Color fundus photograph, 2212x1659px: 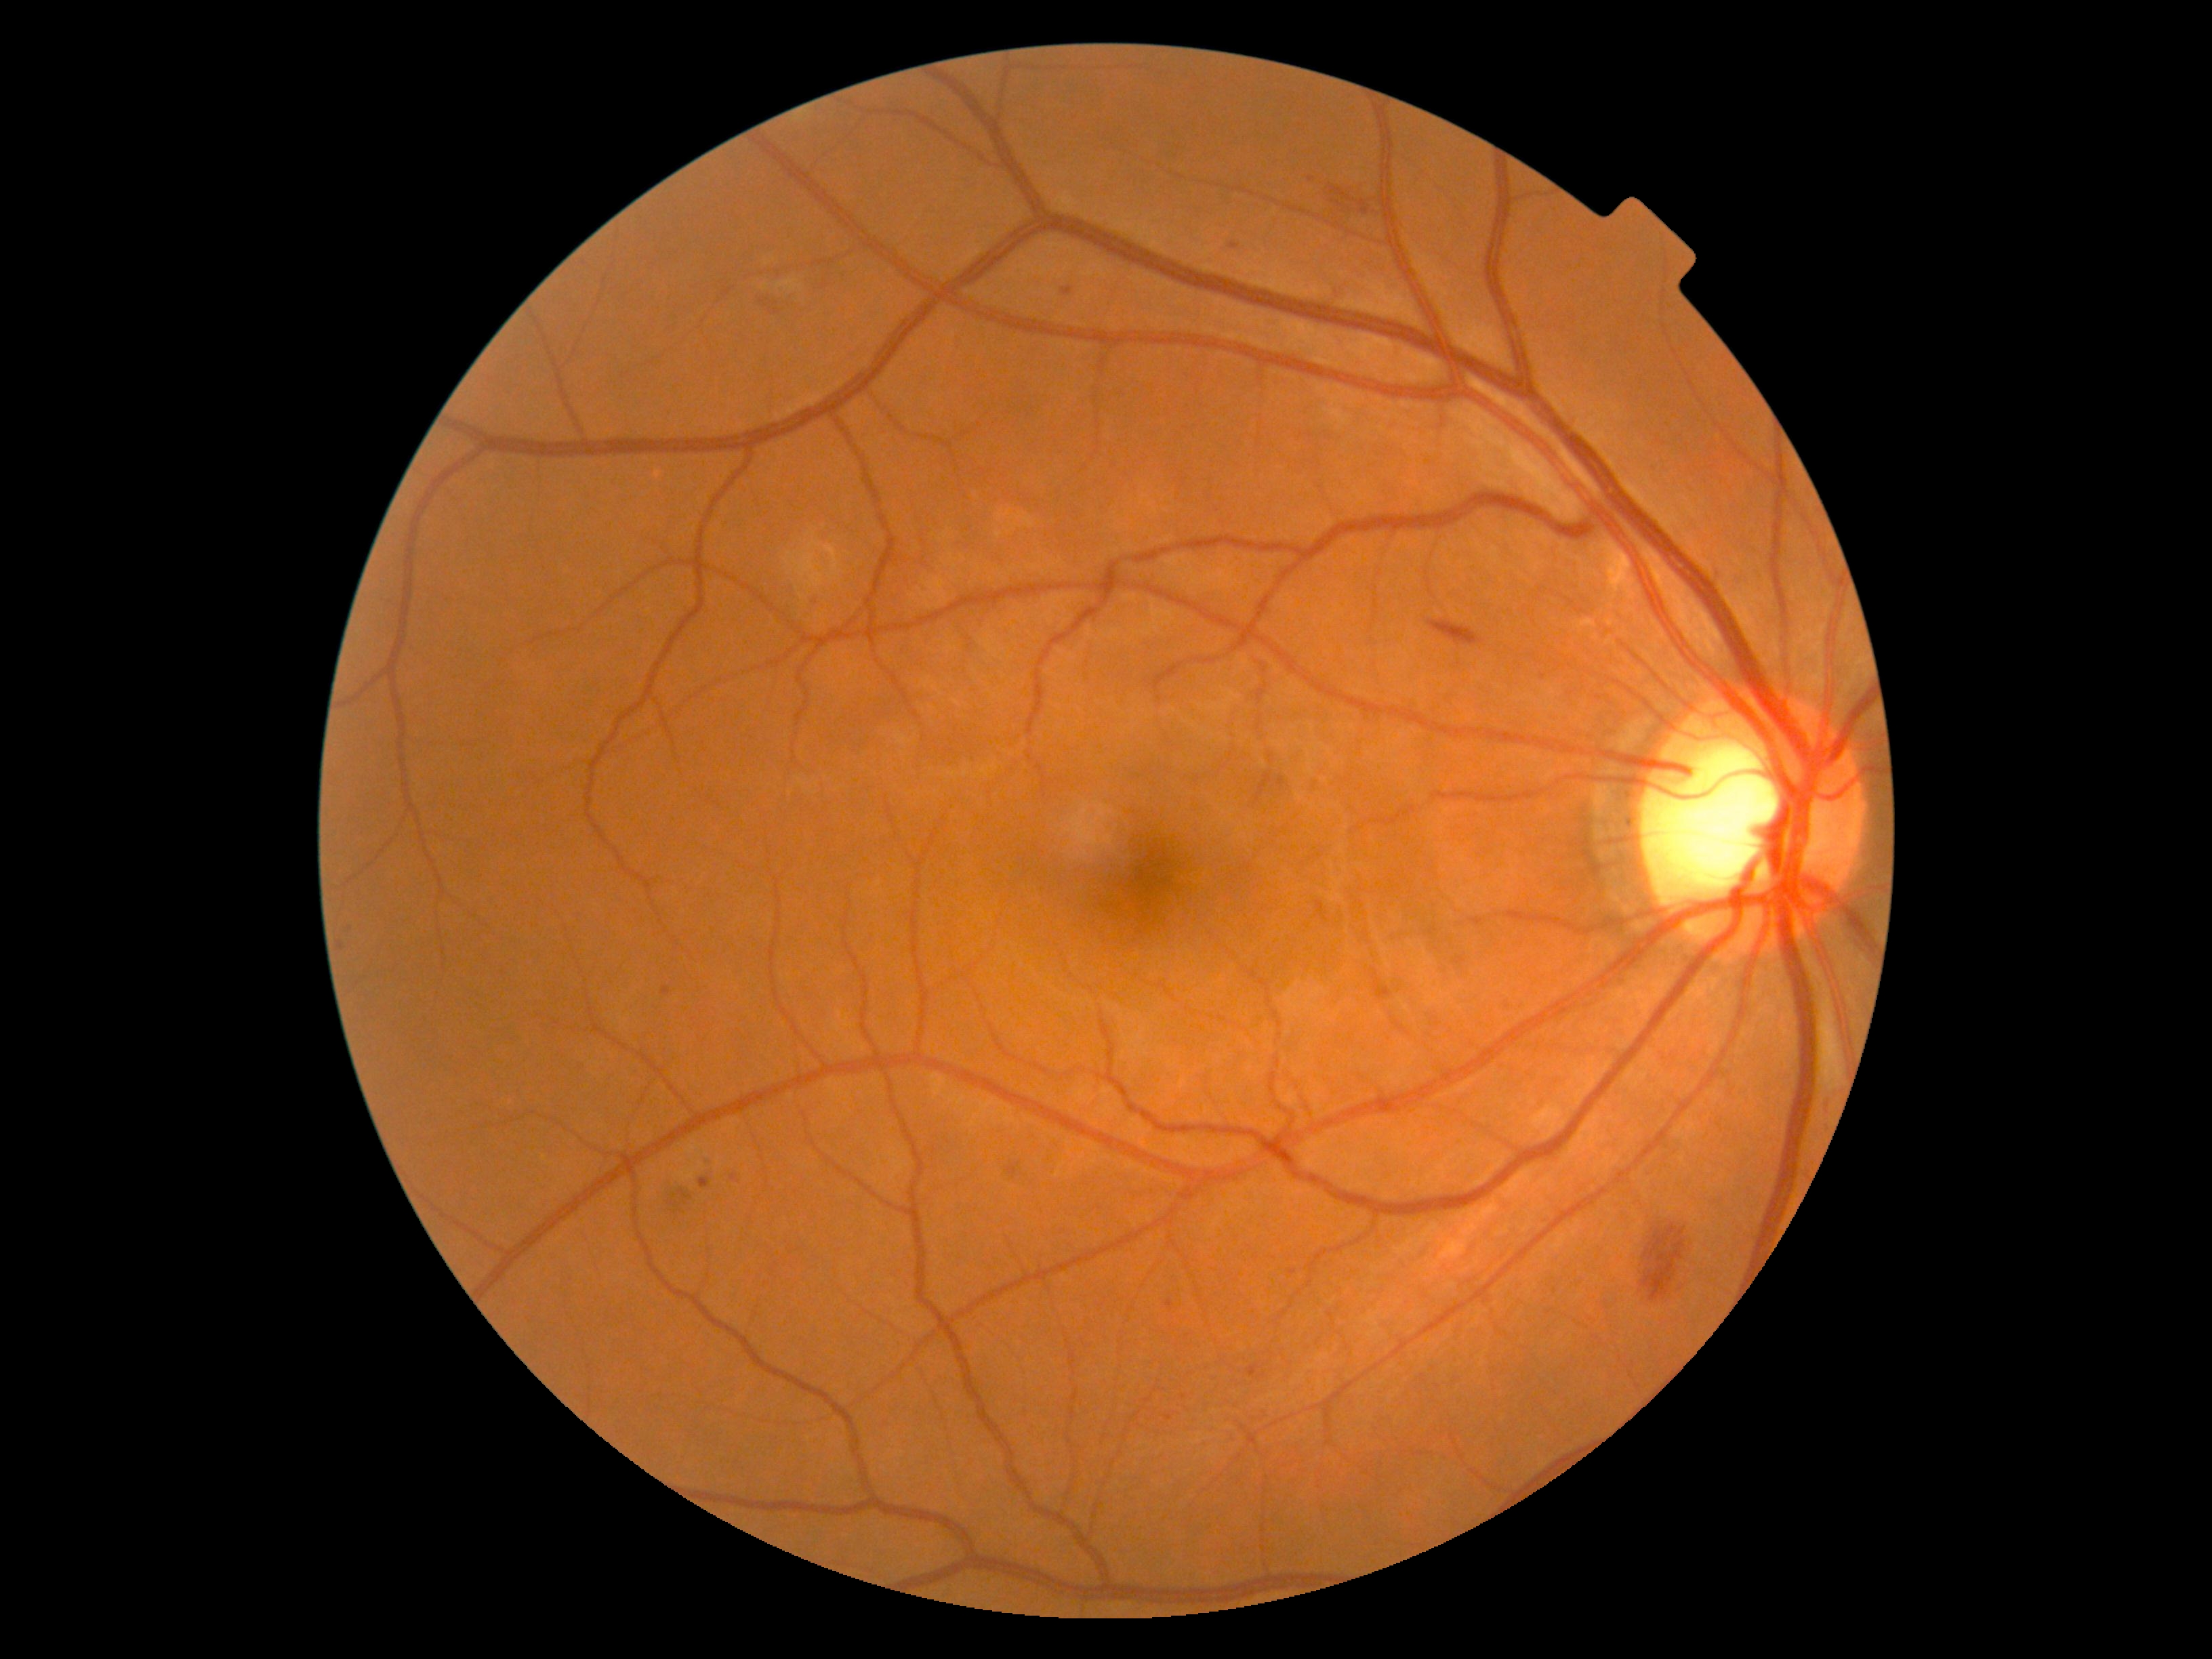

Diabetic retinopathy grade: 2. Soft exudates identified at BBox(777, 280, 803, 292), BBox(762, 284, 769, 292). Soft exudates (small, approximate centers) near {"x": 767, "y": 262}. Microaneurysms include those at BBox(338, 941, 344, 949), BBox(1165, 1414, 1173, 1420), BBox(1006, 1164, 1020, 1177), BBox(700, 1155, 711, 1164), BBox(700, 1177, 711, 1188), BBox(661, 986, 670, 996), BBox(1062, 288, 1073, 295), BBox(802, 598, 815, 608), BBox(1277, 777, 1286, 788), BBox(1290, 1269, 1298, 1273), BBox(1248, 1363, 1263, 1378). Microaneurysms (small, approximate centers) near {"x": 1234, "y": 247}, {"x": 734, "y": 1177}, {"x": 350, "y": 928}, {"x": 1311, "y": 180}, {"x": 1169, "y": 1303}. Hemorrhages identified at BBox(758, 295, 781, 311), BBox(1428, 620, 1483, 646), BBox(1332, 200, 1343, 207), BBox(1329, 185, 1370, 215), BBox(1641, 1223, 1685, 1302), BBox(659, 1187, 691, 1202). No hard exudates identified.